45-degree field of view · color fundus photograph
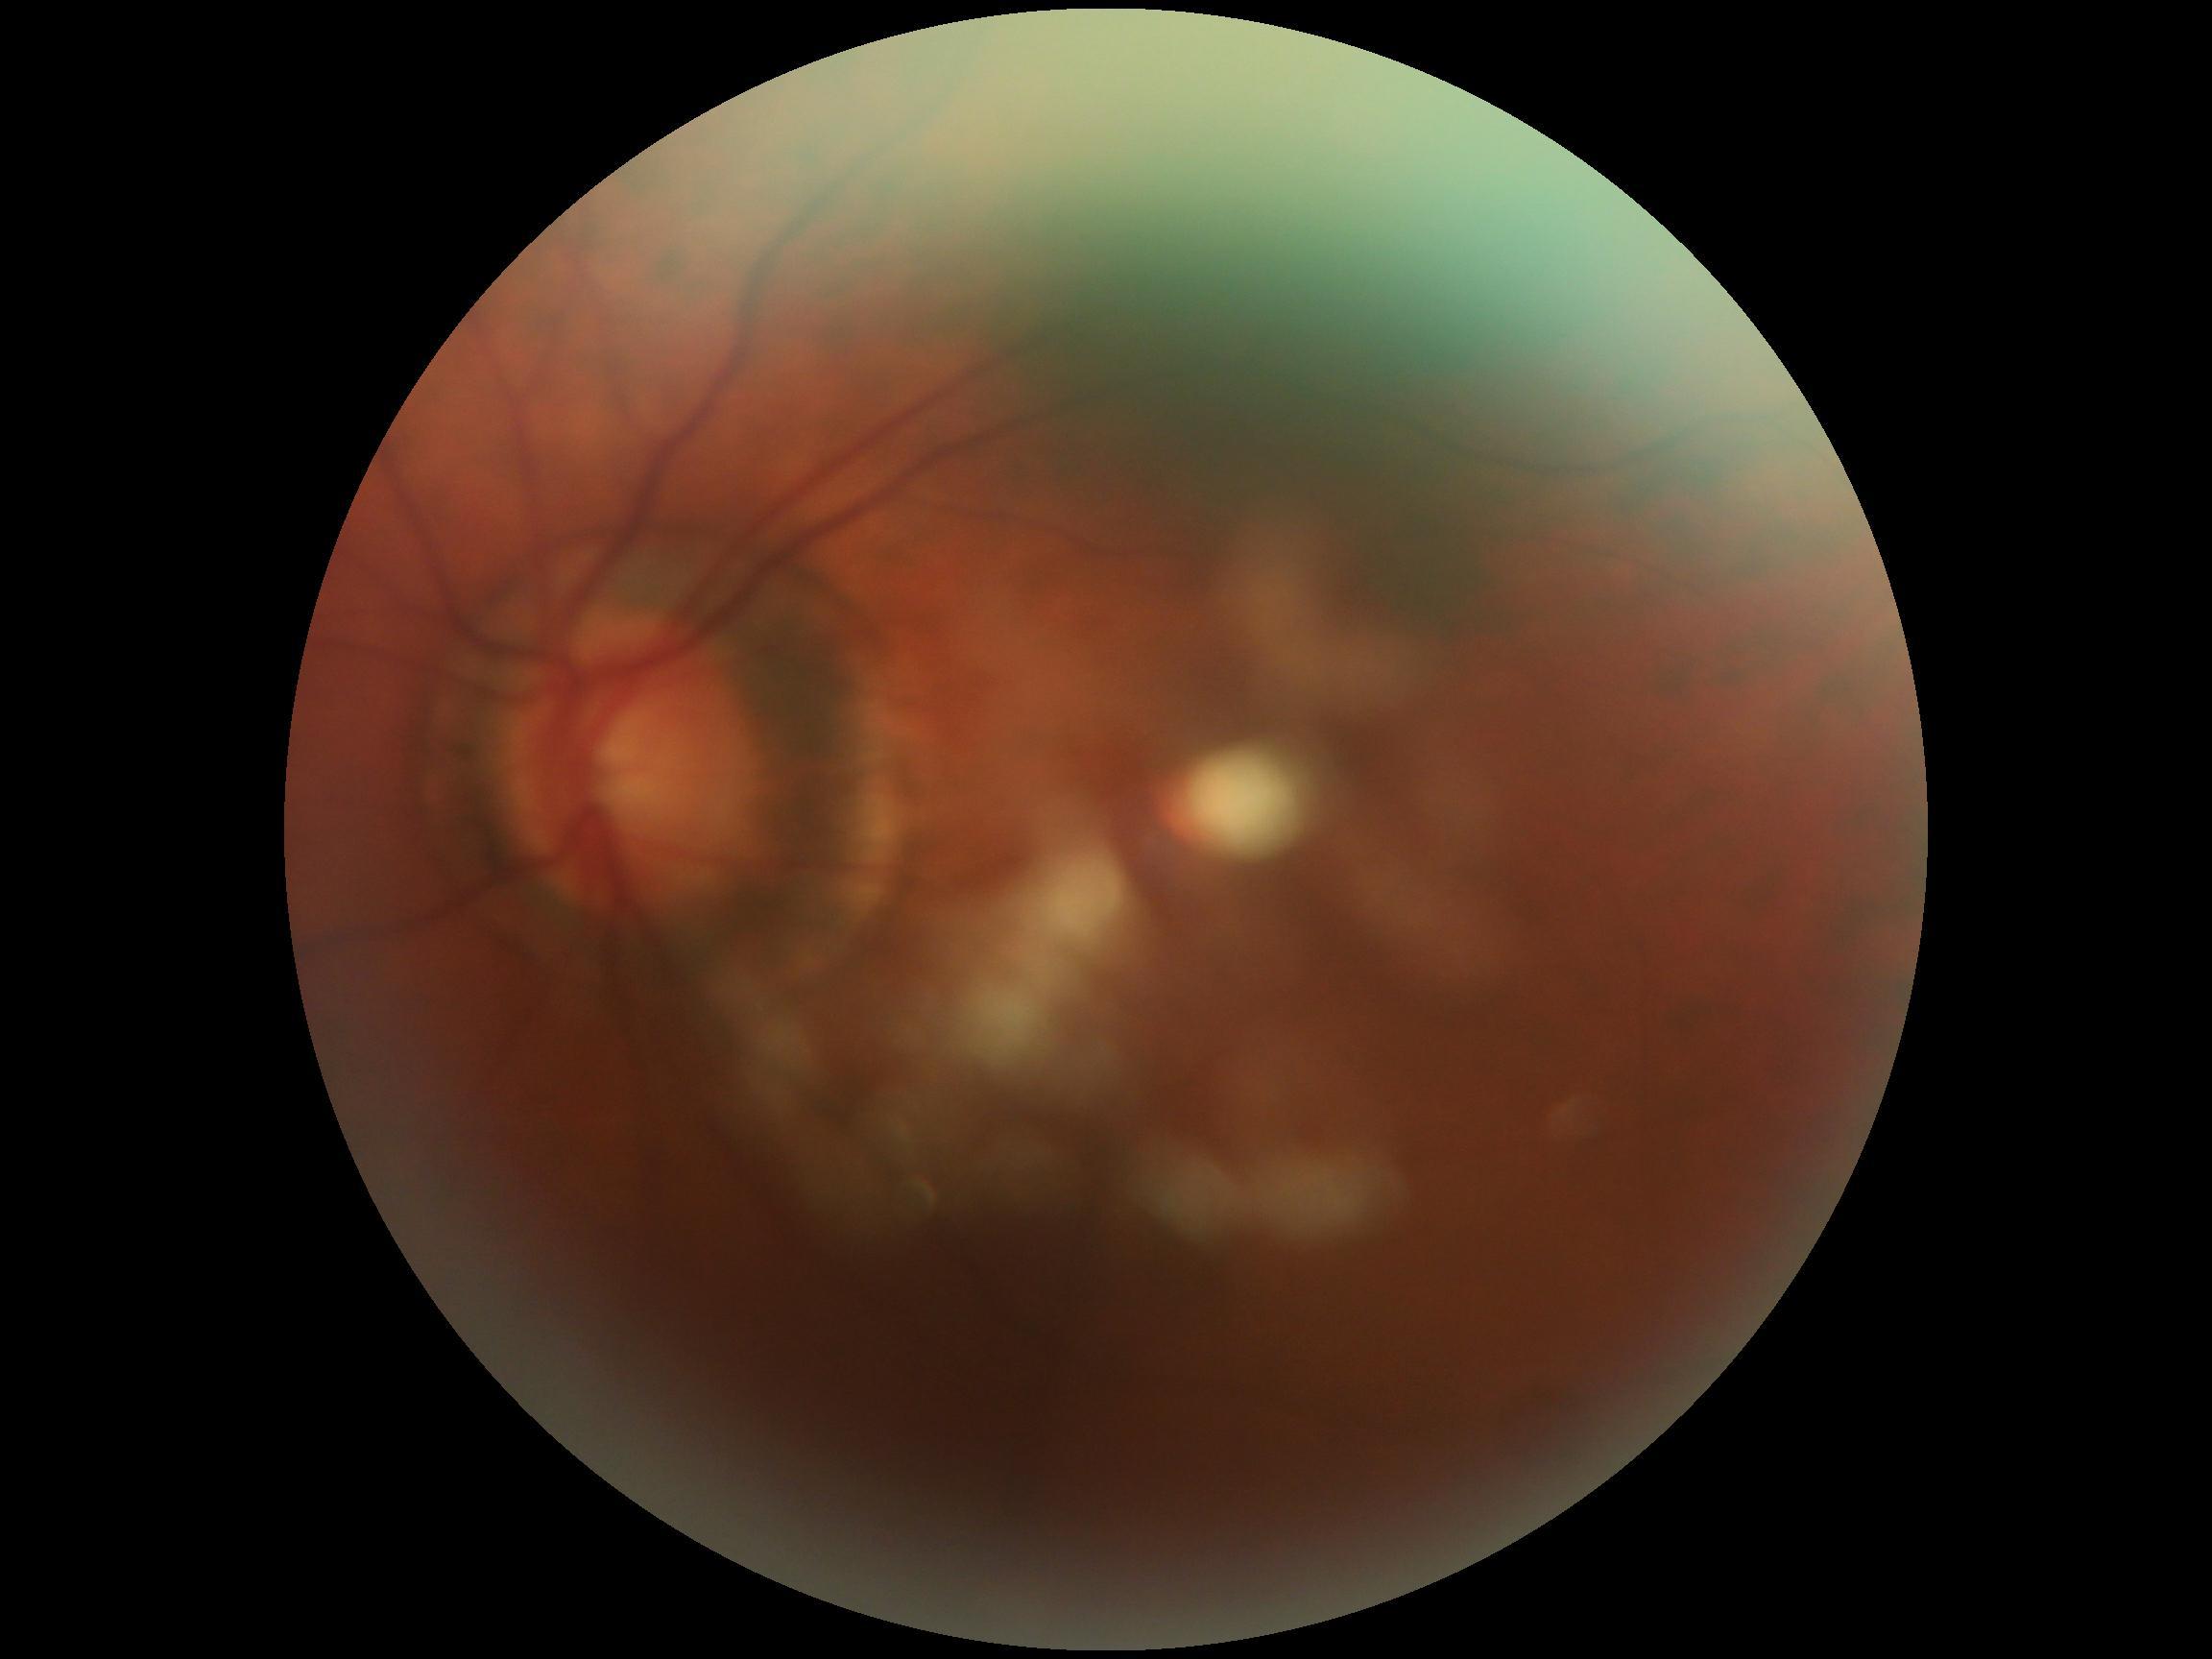 DR severity is grade 0.